Wide-field fundus photograph from neonatal ROP screening: 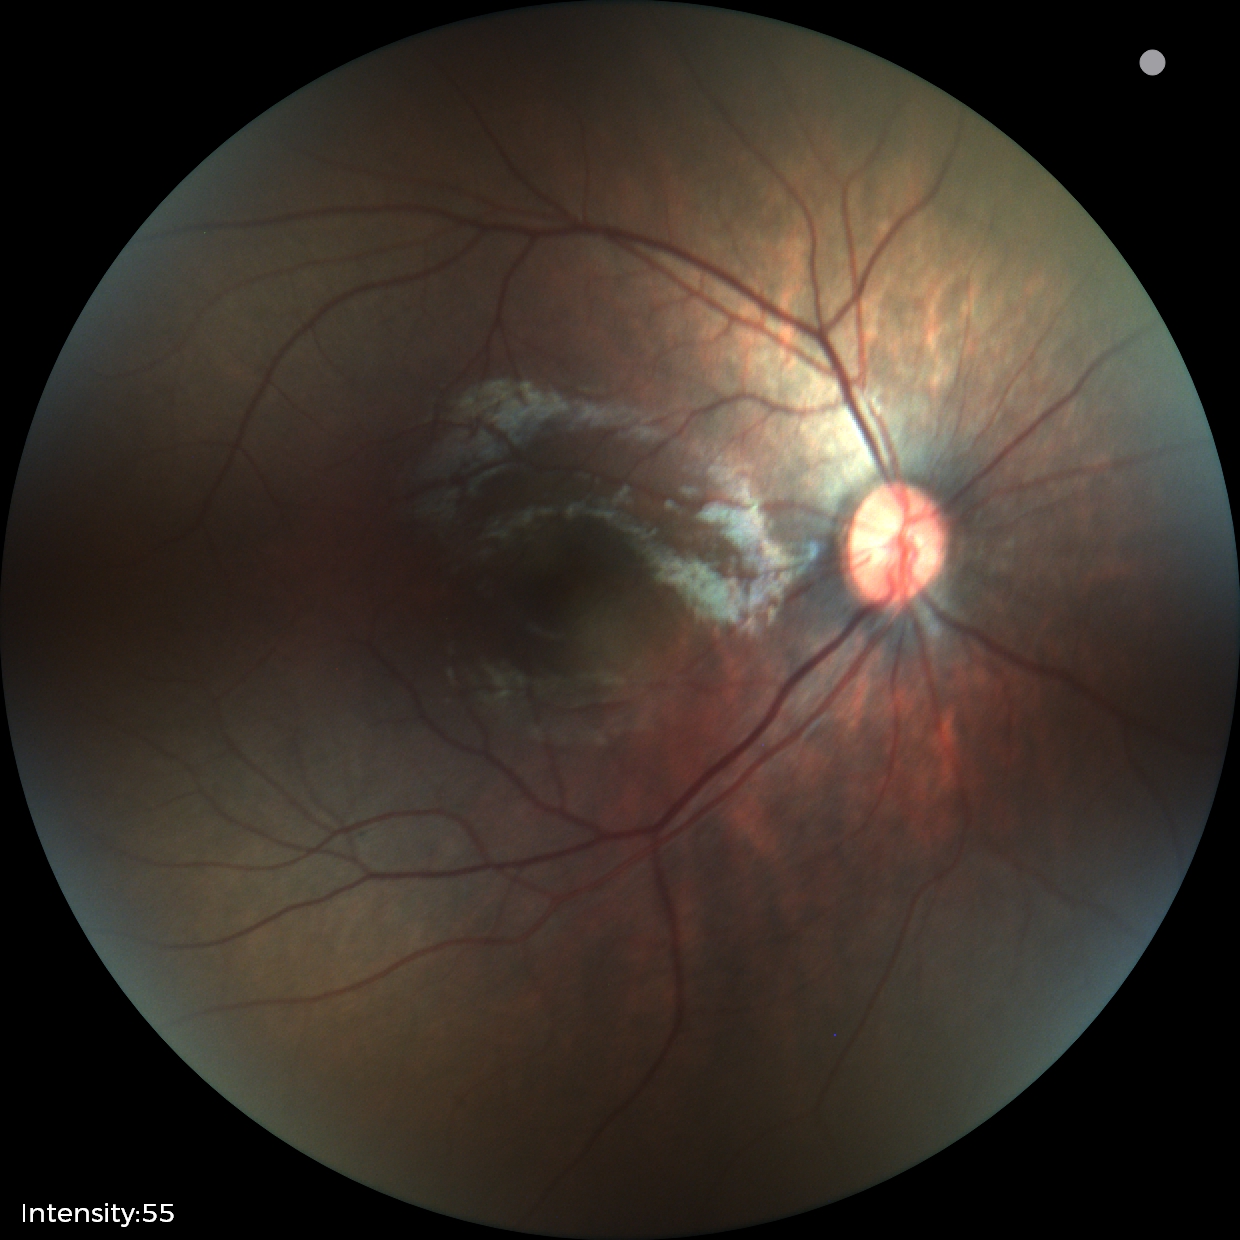
Physiological retinal appearance for postconceptual age.